Pediatric wide-field fundus photograph. 640x480px:
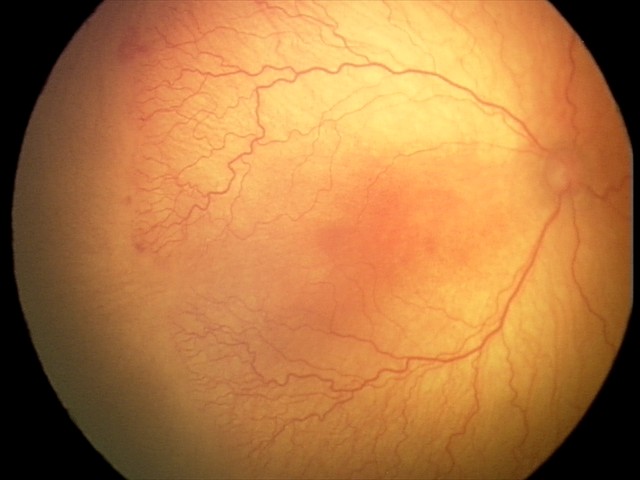 Q: Plus disease status?
A: plus disease
Q: What was the screening finding?
A: A-ROP (aggressive ROP)